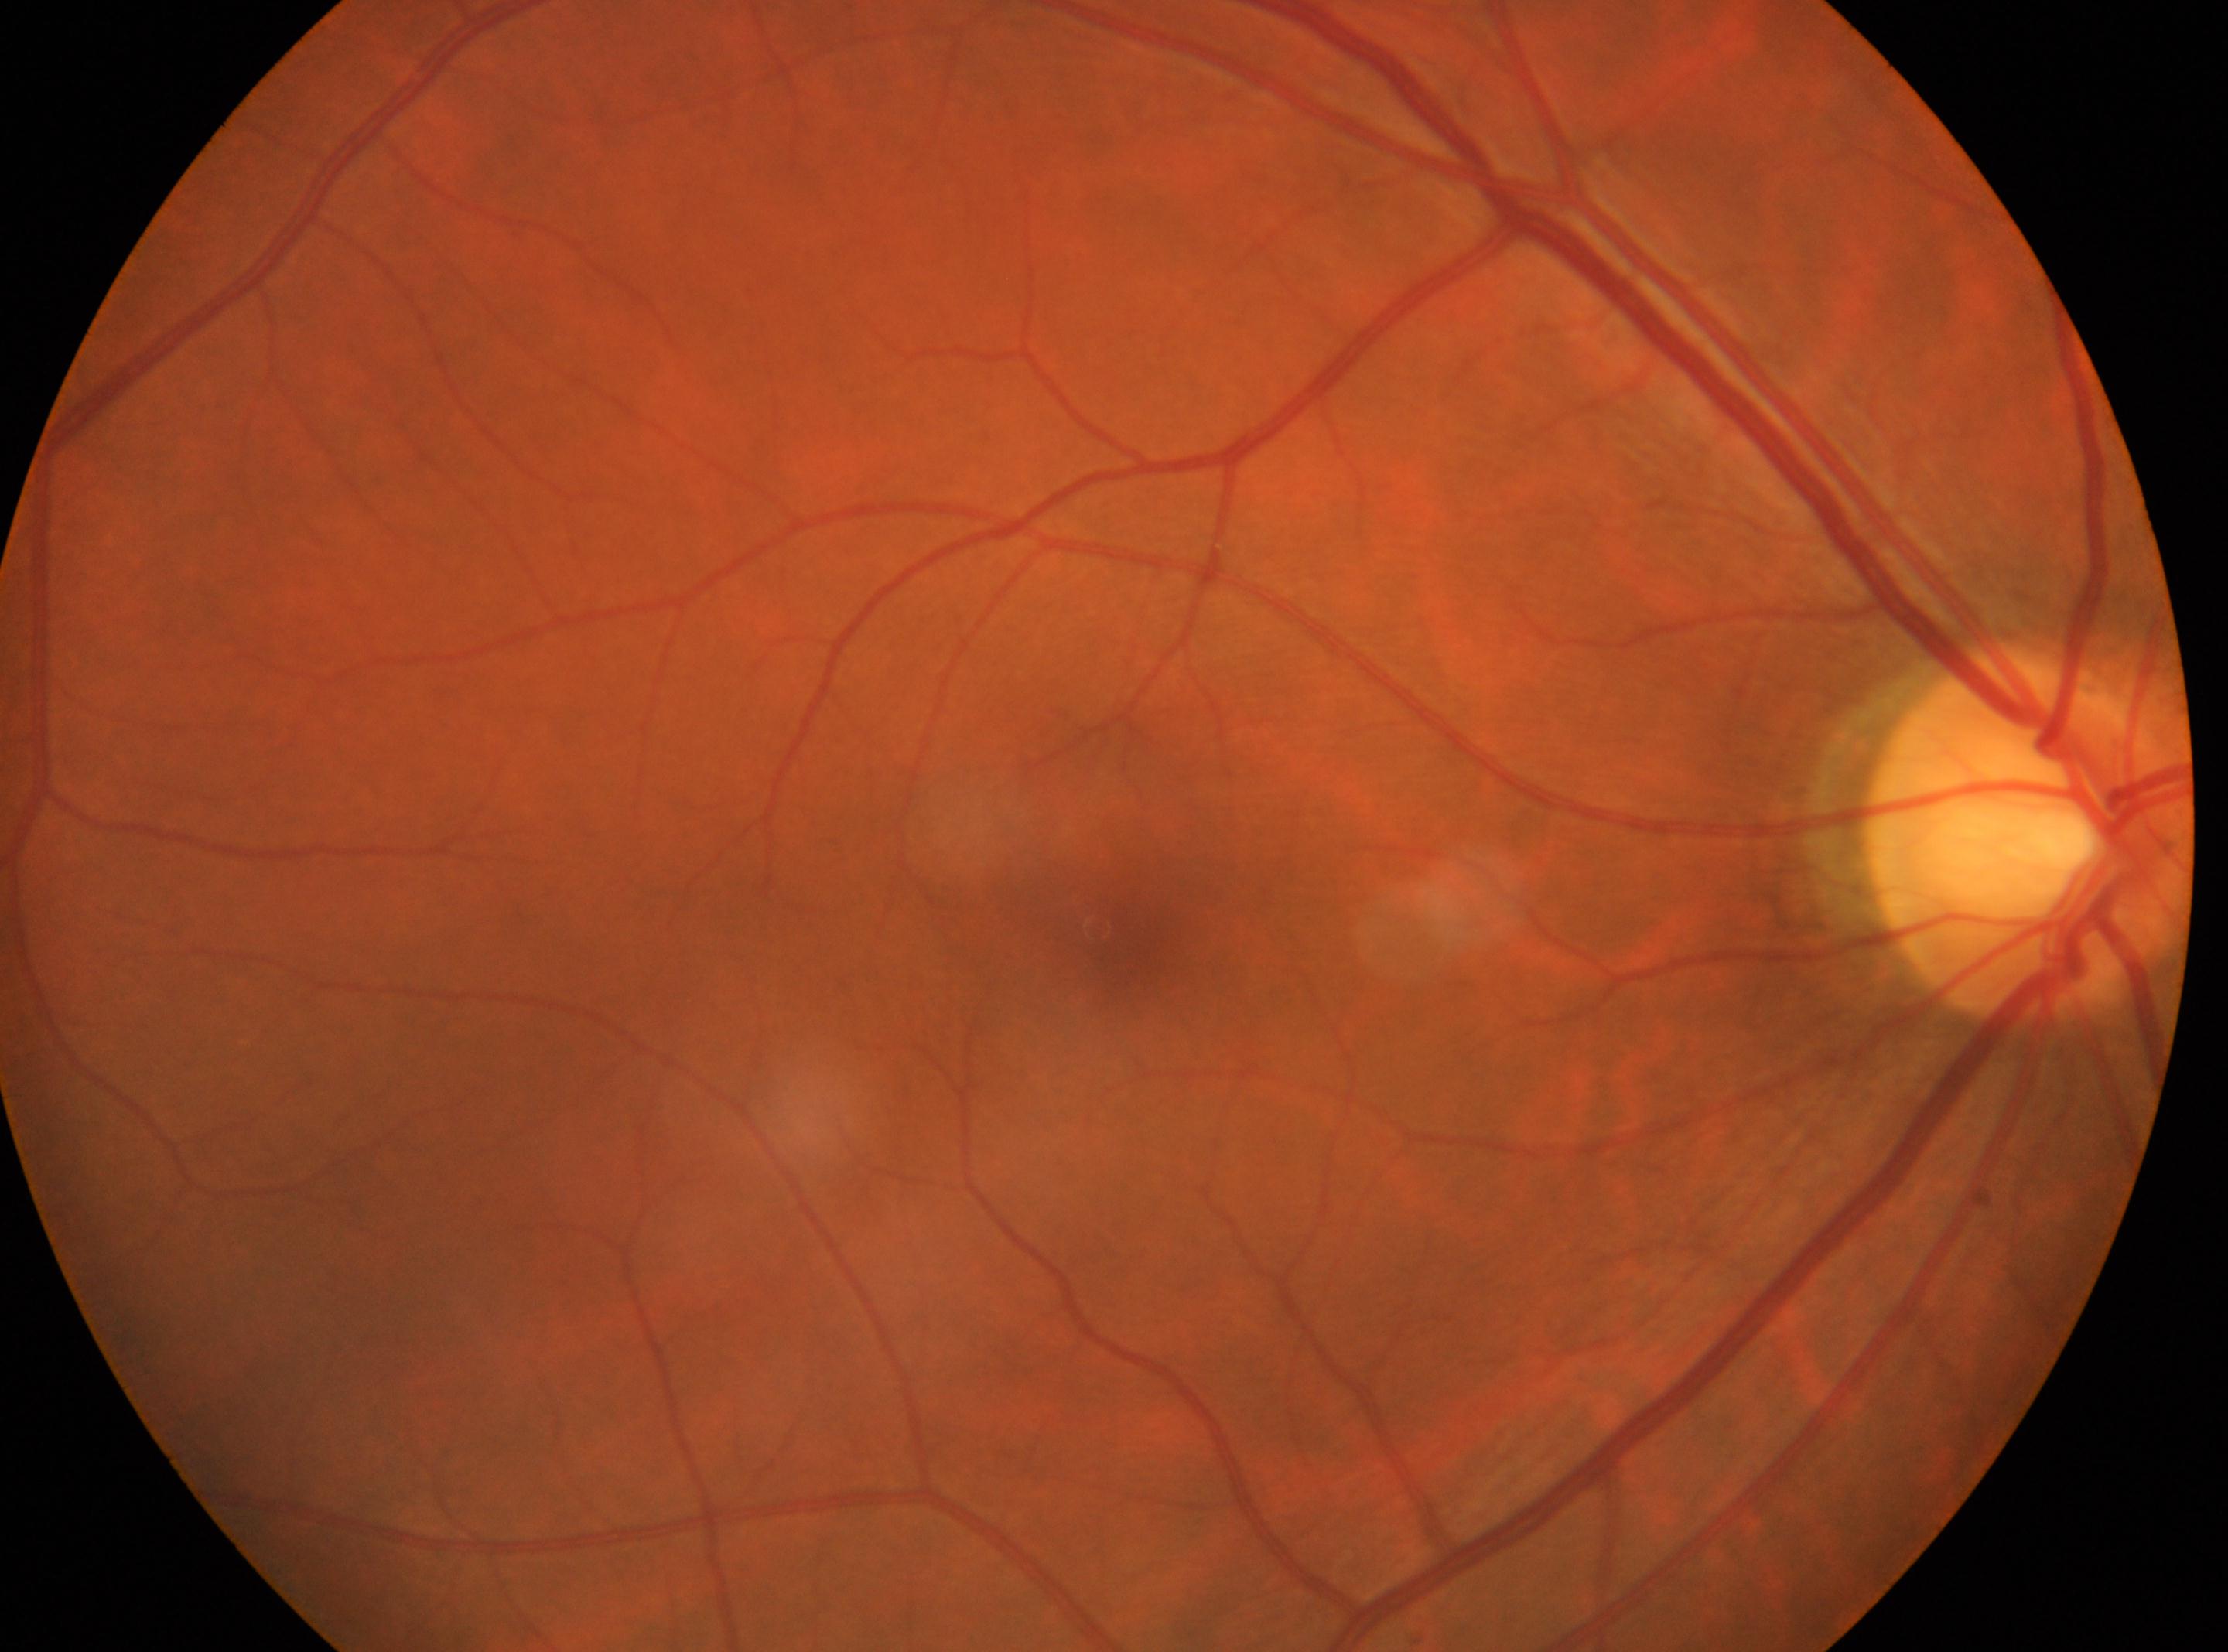

Eye: the right eye. Diabetic retinopathy is grade 0 (no apparent retinopathy). Fovea located at x=1117, y=933. The optic disc center is at x=2030, y=832.